45° FOV; no pharmacologic dilation; posterior pole photograph; camera: NIDEK AFC-230 — 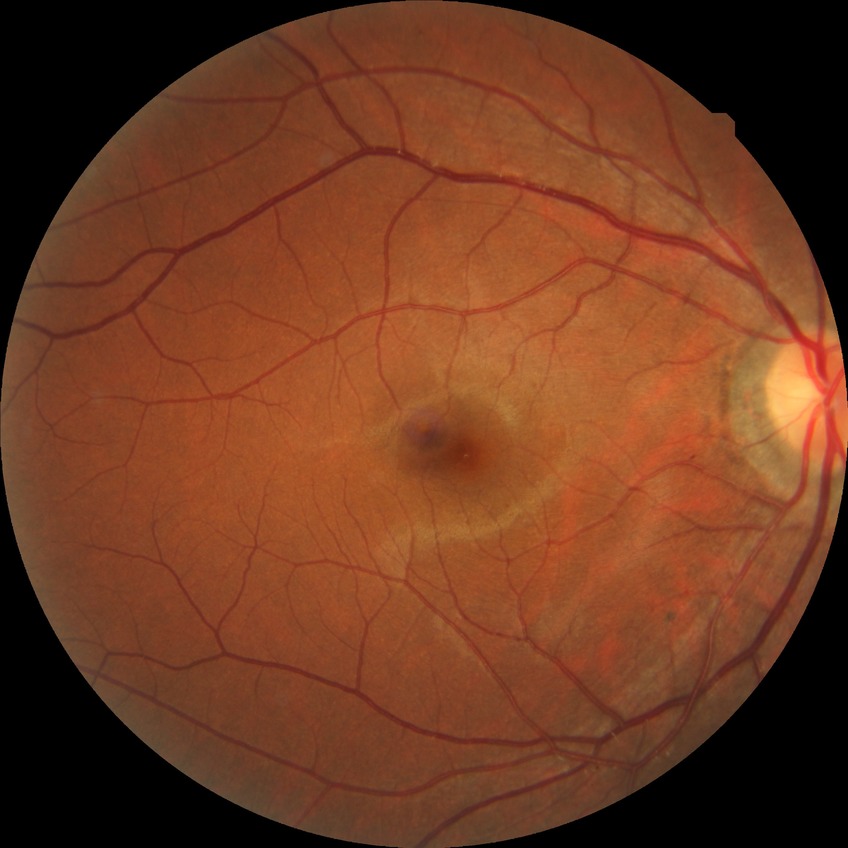 diabetic retinopathy (DR)=NDR (no diabetic retinopathy).